45-degree field of view. Retinal fundus photograph:
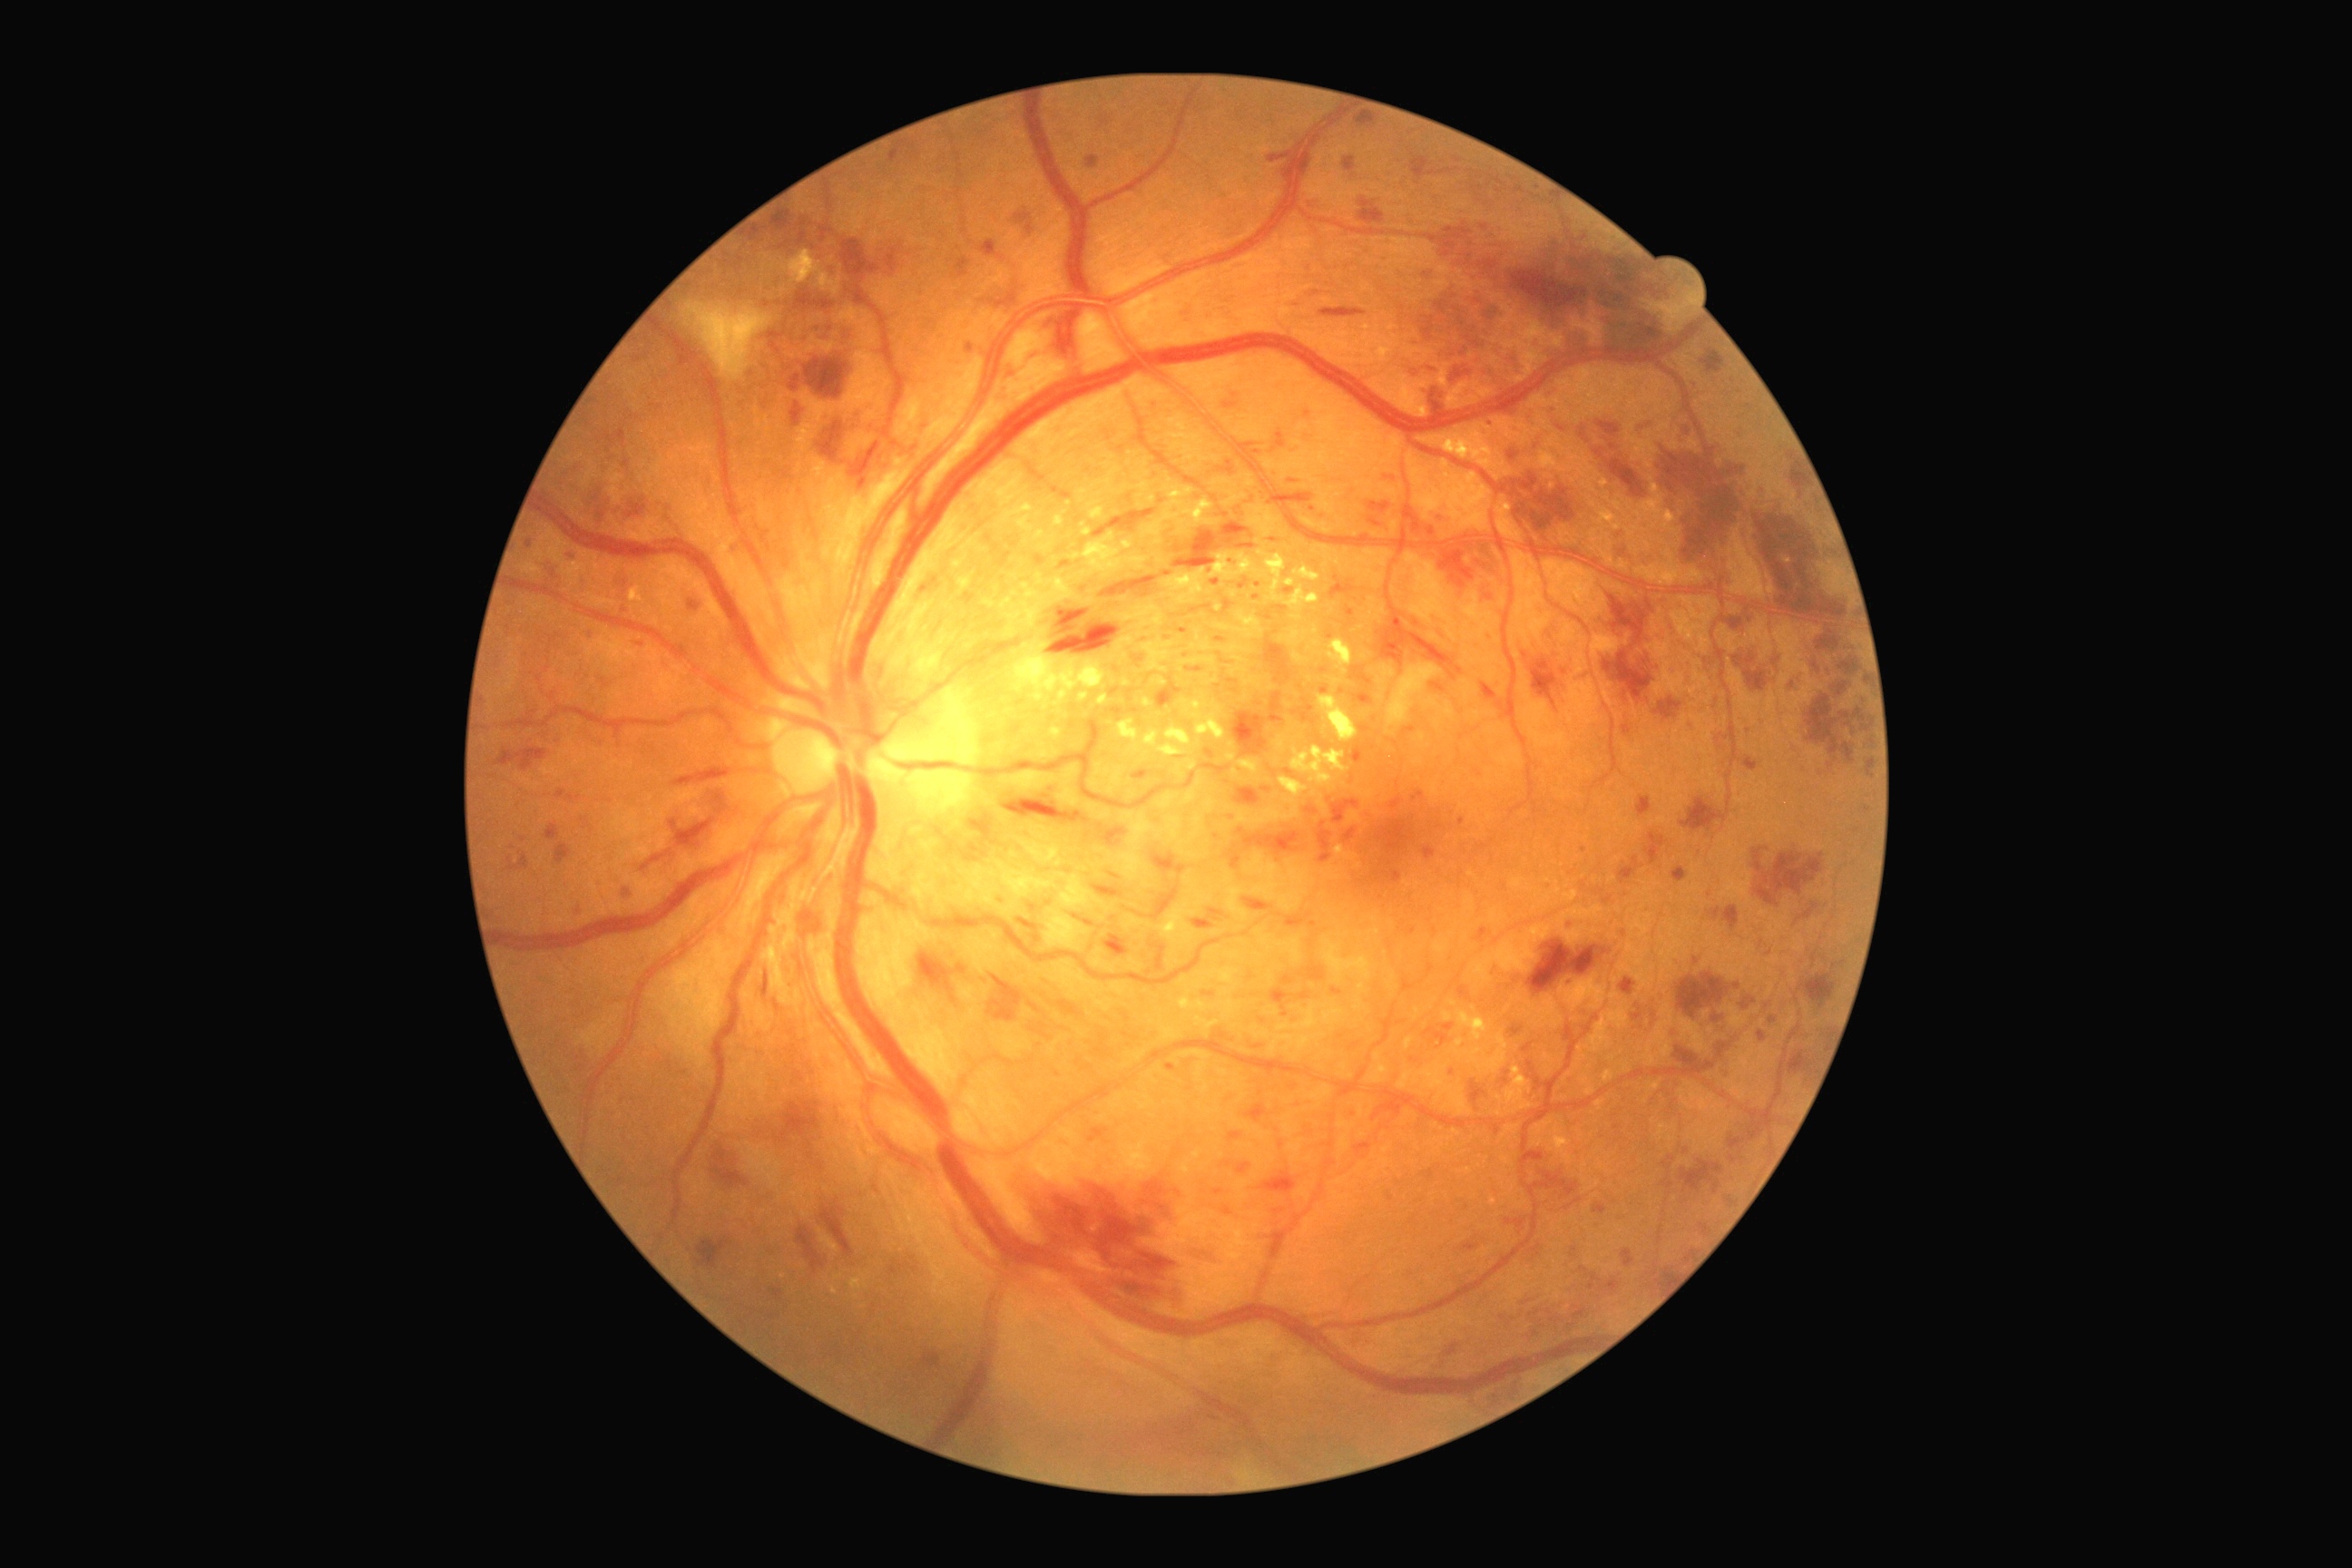
DR severity is severe NPDR (grade 3) — more than 20 intraretinal hemorrhages in each of 4 quadrants, definite venous beading in 2 or more quadrants, or prominent intraretinal microvascular abnormalities in 1 or more quadrants, with no signs of proliferative retinopathy.
EXs include lesions at {"left": 1017, "top": 516, "right": 1034, "bottom": 531} | {"left": 1331, "top": 680, "right": 1344, "bottom": 687} | {"left": 1181, "top": 656, "right": 1217, "bottom": 671} | {"left": 1406, "top": 1037, "right": 1415, "bottom": 1050} | {"left": 1228, "top": 778, "right": 1309, "bottom": 830} | {"left": 1335, "top": 847, "right": 1358, "bottom": 861} | {"left": 1144, "top": 698, "right": 1152, "bottom": 709} | {"left": 1215, "top": 609, "right": 1264, "bottom": 640} | {"left": 1197, "top": 631, "right": 1200, "bottom": 642} | {"left": 1097, "top": 694, "right": 1110, "bottom": 705} | {"left": 1326, "top": 640, "right": 1353, "bottom": 676} | {"left": 1226, "top": 754, "right": 1235, "bottom": 761} | {"left": 783, "top": 250, "right": 843, "bottom": 297}.
EXs (small, approximate centers) near <point>1218, 608</point> | <point>1084, 525</point> | <point>1269, 781</point> | <point>1070, 580</point>.
MAs include lesions at {"left": 1293, "top": 705, "right": 1317, "bottom": 725} | {"left": 1190, "top": 605, "right": 1211, "bottom": 614} | {"left": 1478, "top": 928, "right": 1487, "bottom": 941} | {"left": 1019, "top": 919, "right": 1039, "bottom": 932} | {"left": 1592, "top": 1202, "right": 1607, "bottom": 1215} | {"left": 1213, "top": 1190, "right": 1224, "bottom": 1197} | {"left": 816, "top": 1162, "right": 825, "bottom": 1171} | {"left": 1230, "top": 1132, "right": 1242, "bottom": 1142} | {"left": 1117, "top": 447, "right": 1126, "bottom": 455} | {"left": 1084, "top": 921, "right": 1095, "bottom": 926} | {"left": 790, "top": 402, "right": 803, "bottom": 427} | {"left": 1239, "top": 580, "right": 1248, "bottom": 591}.
MAs (small, approximate centers) near <point>1258, 586</point> | <point>1695, 384</point> | <point>1608, 900</point> | <point>804, 223</point> | <point>1076, 917</point> | <point>569, 560</point> | <point>1741, 438</point>.
HEs include lesions at {"left": 591, "top": 489, "right": 614, "bottom": 520} | {"left": 1173, "top": 522, "right": 1251, "bottom": 569} | {"left": 1856, "top": 710, "right": 1863, "bottom": 718} | {"left": 1747, "top": 612, "right": 1756, "bottom": 625} | {"left": 1242, "top": 897, "right": 1271, "bottom": 912} | {"left": 1727, "top": 1113, "right": 1774, "bottom": 1150} | {"left": 1609, "top": 460, "right": 1645, "bottom": 498} | {"left": 1636, "top": 420, "right": 1652, "bottom": 436} | {"left": 1600, "top": 589, "right": 1661, "bottom": 710} | {"left": 816, "top": 422, "right": 845, "bottom": 464} | {"left": 1723, "top": 906, "right": 1740, "bottom": 930} | {"left": 1422, "top": 384, "right": 1451, "bottom": 418} | {"left": 1654, "top": 698, "right": 1683, "bottom": 720} | {"left": 1409, "top": 632, "right": 1456, "bottom": 680} | {"left": 505, "top": 852, "right": 529, "bottom": 872} | {"left": 1643, "top": 554, "right": 1656, "bottom": 569} | {"left": 1721, "top": 616, "right": 1745, "bottom": 631}.
HEs (small, approximate centers) near <point>1867, 702</point>.